1380x1382px, 45-degree field of view, color fundus image:
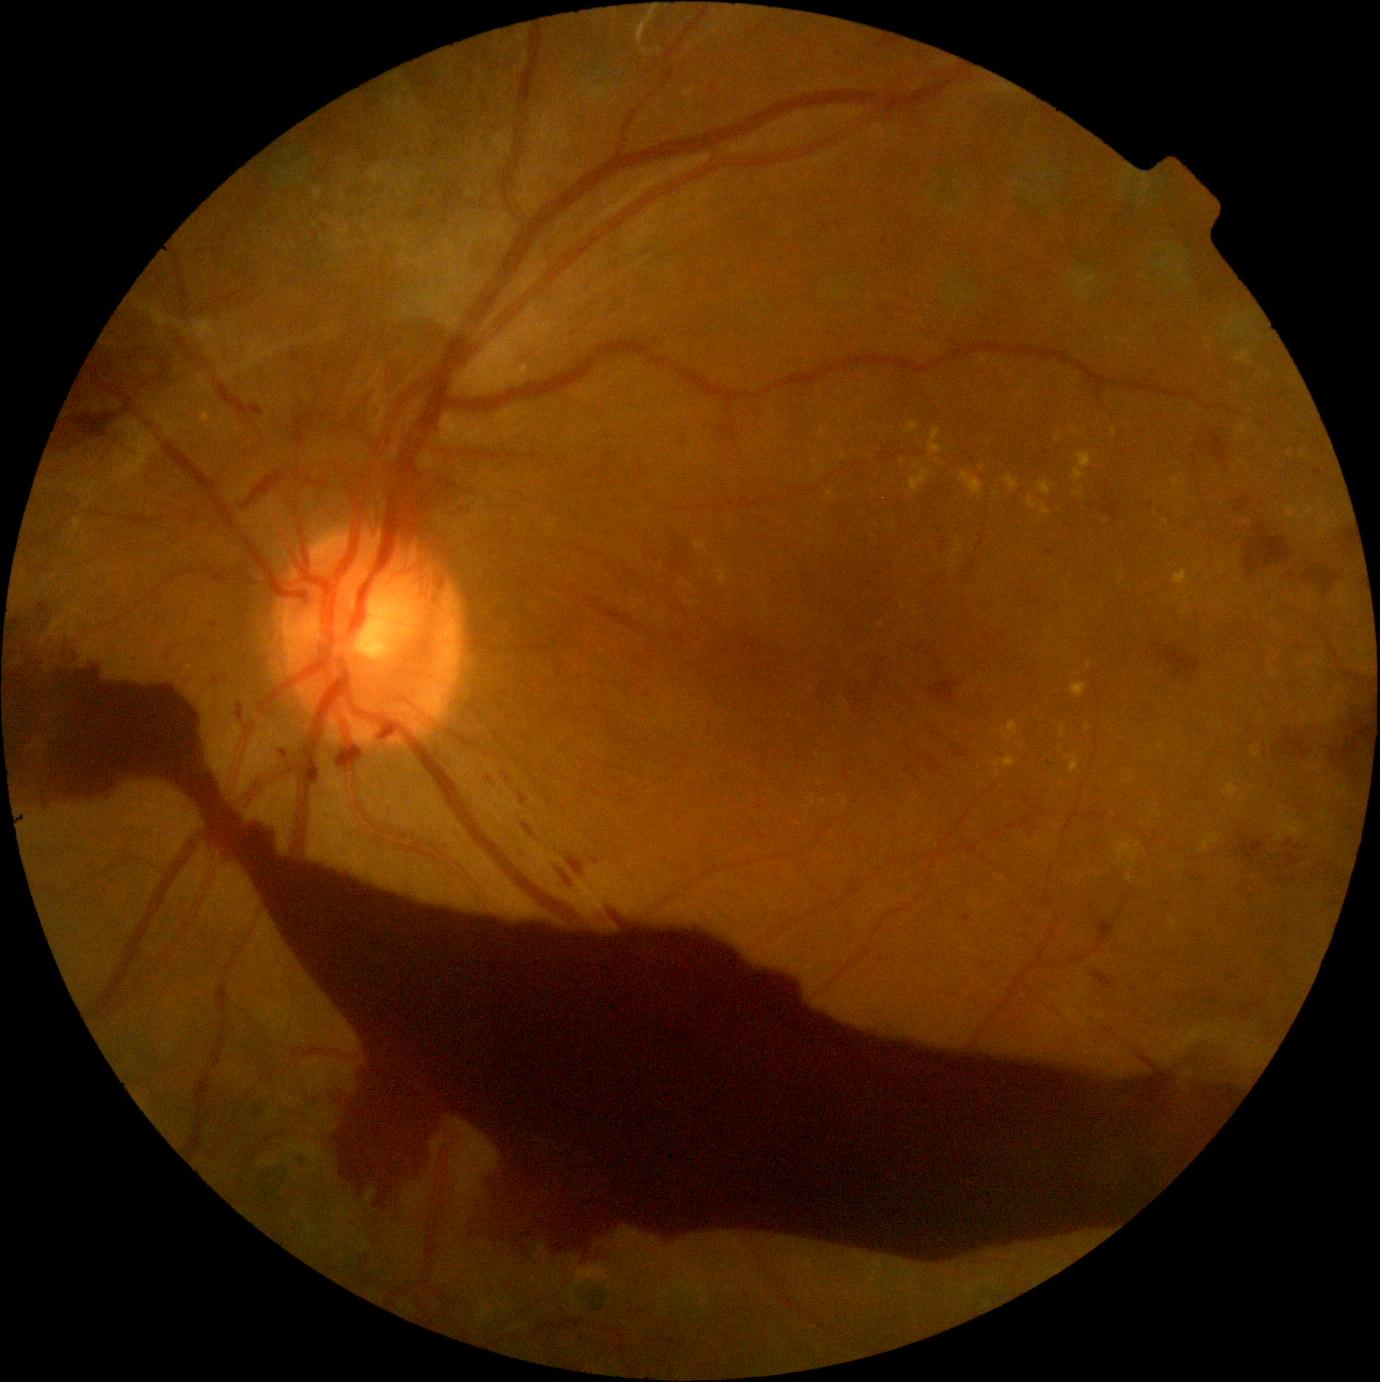 DR stage = grade 4, DR class = proliferative diabetic retinopathy.